Wide-field fundus image from infant ROP screening. 1240 x 1240 pixels.
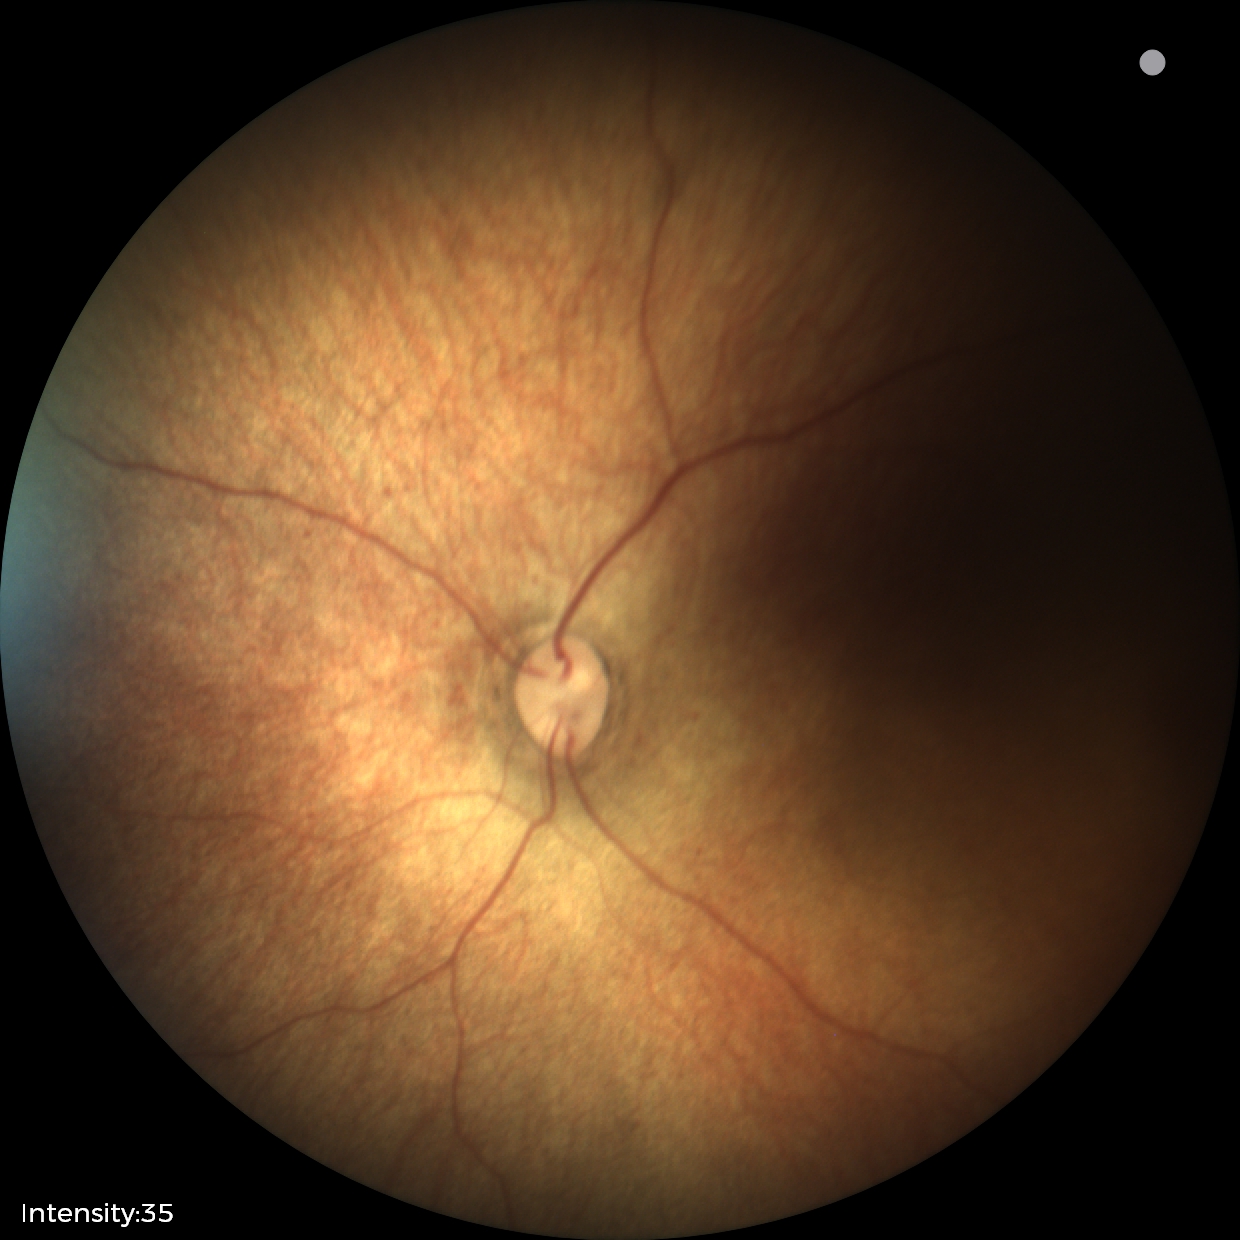 Assessment = normal retinal appearance.